Image size 1240x1240; Phoenix ICON wide-field infant fundus image; camera: Phoenix ICON (100° FOV).
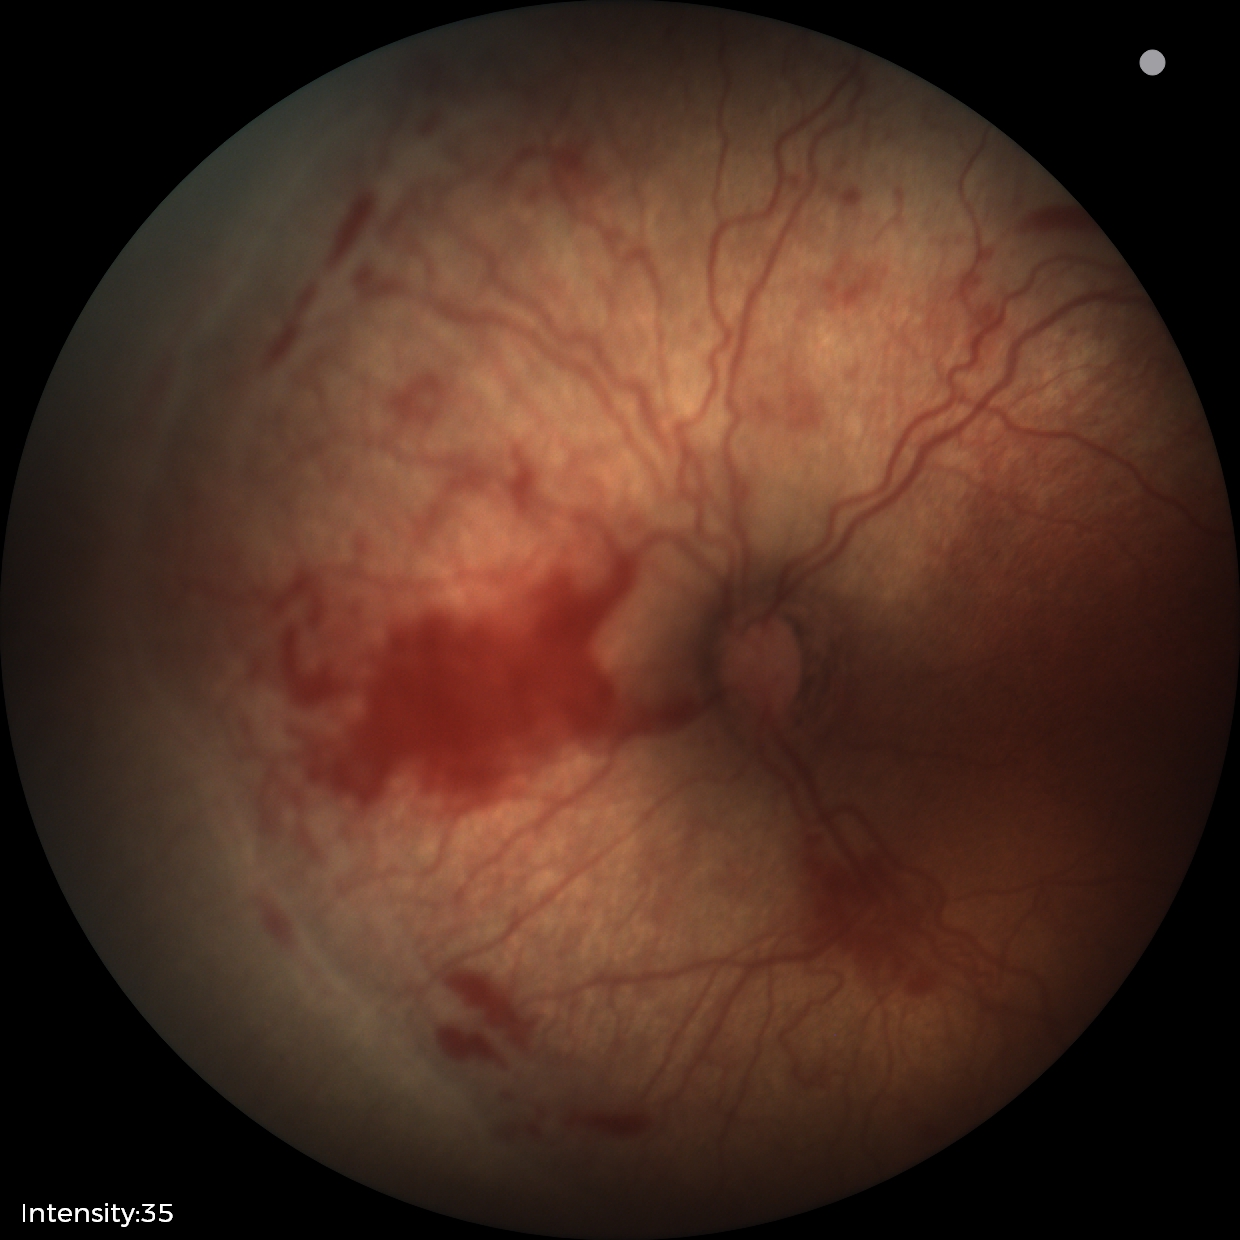 Series diagnosed as retinopathy of prematurity (ROP) stage 2.
With plus disease.